848x848px; FOV: 45 degrees; retinal fundus photograph; without pupil dilation — 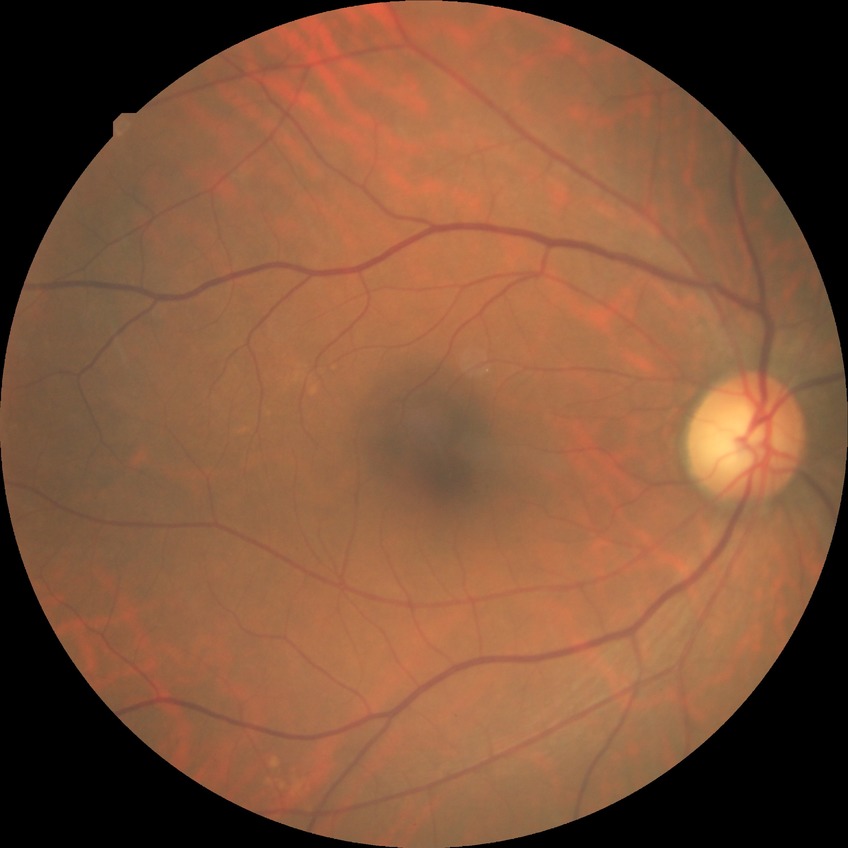
Diabetic retinopathy grade is no diabetic retinopathy.